45-degree field of view: 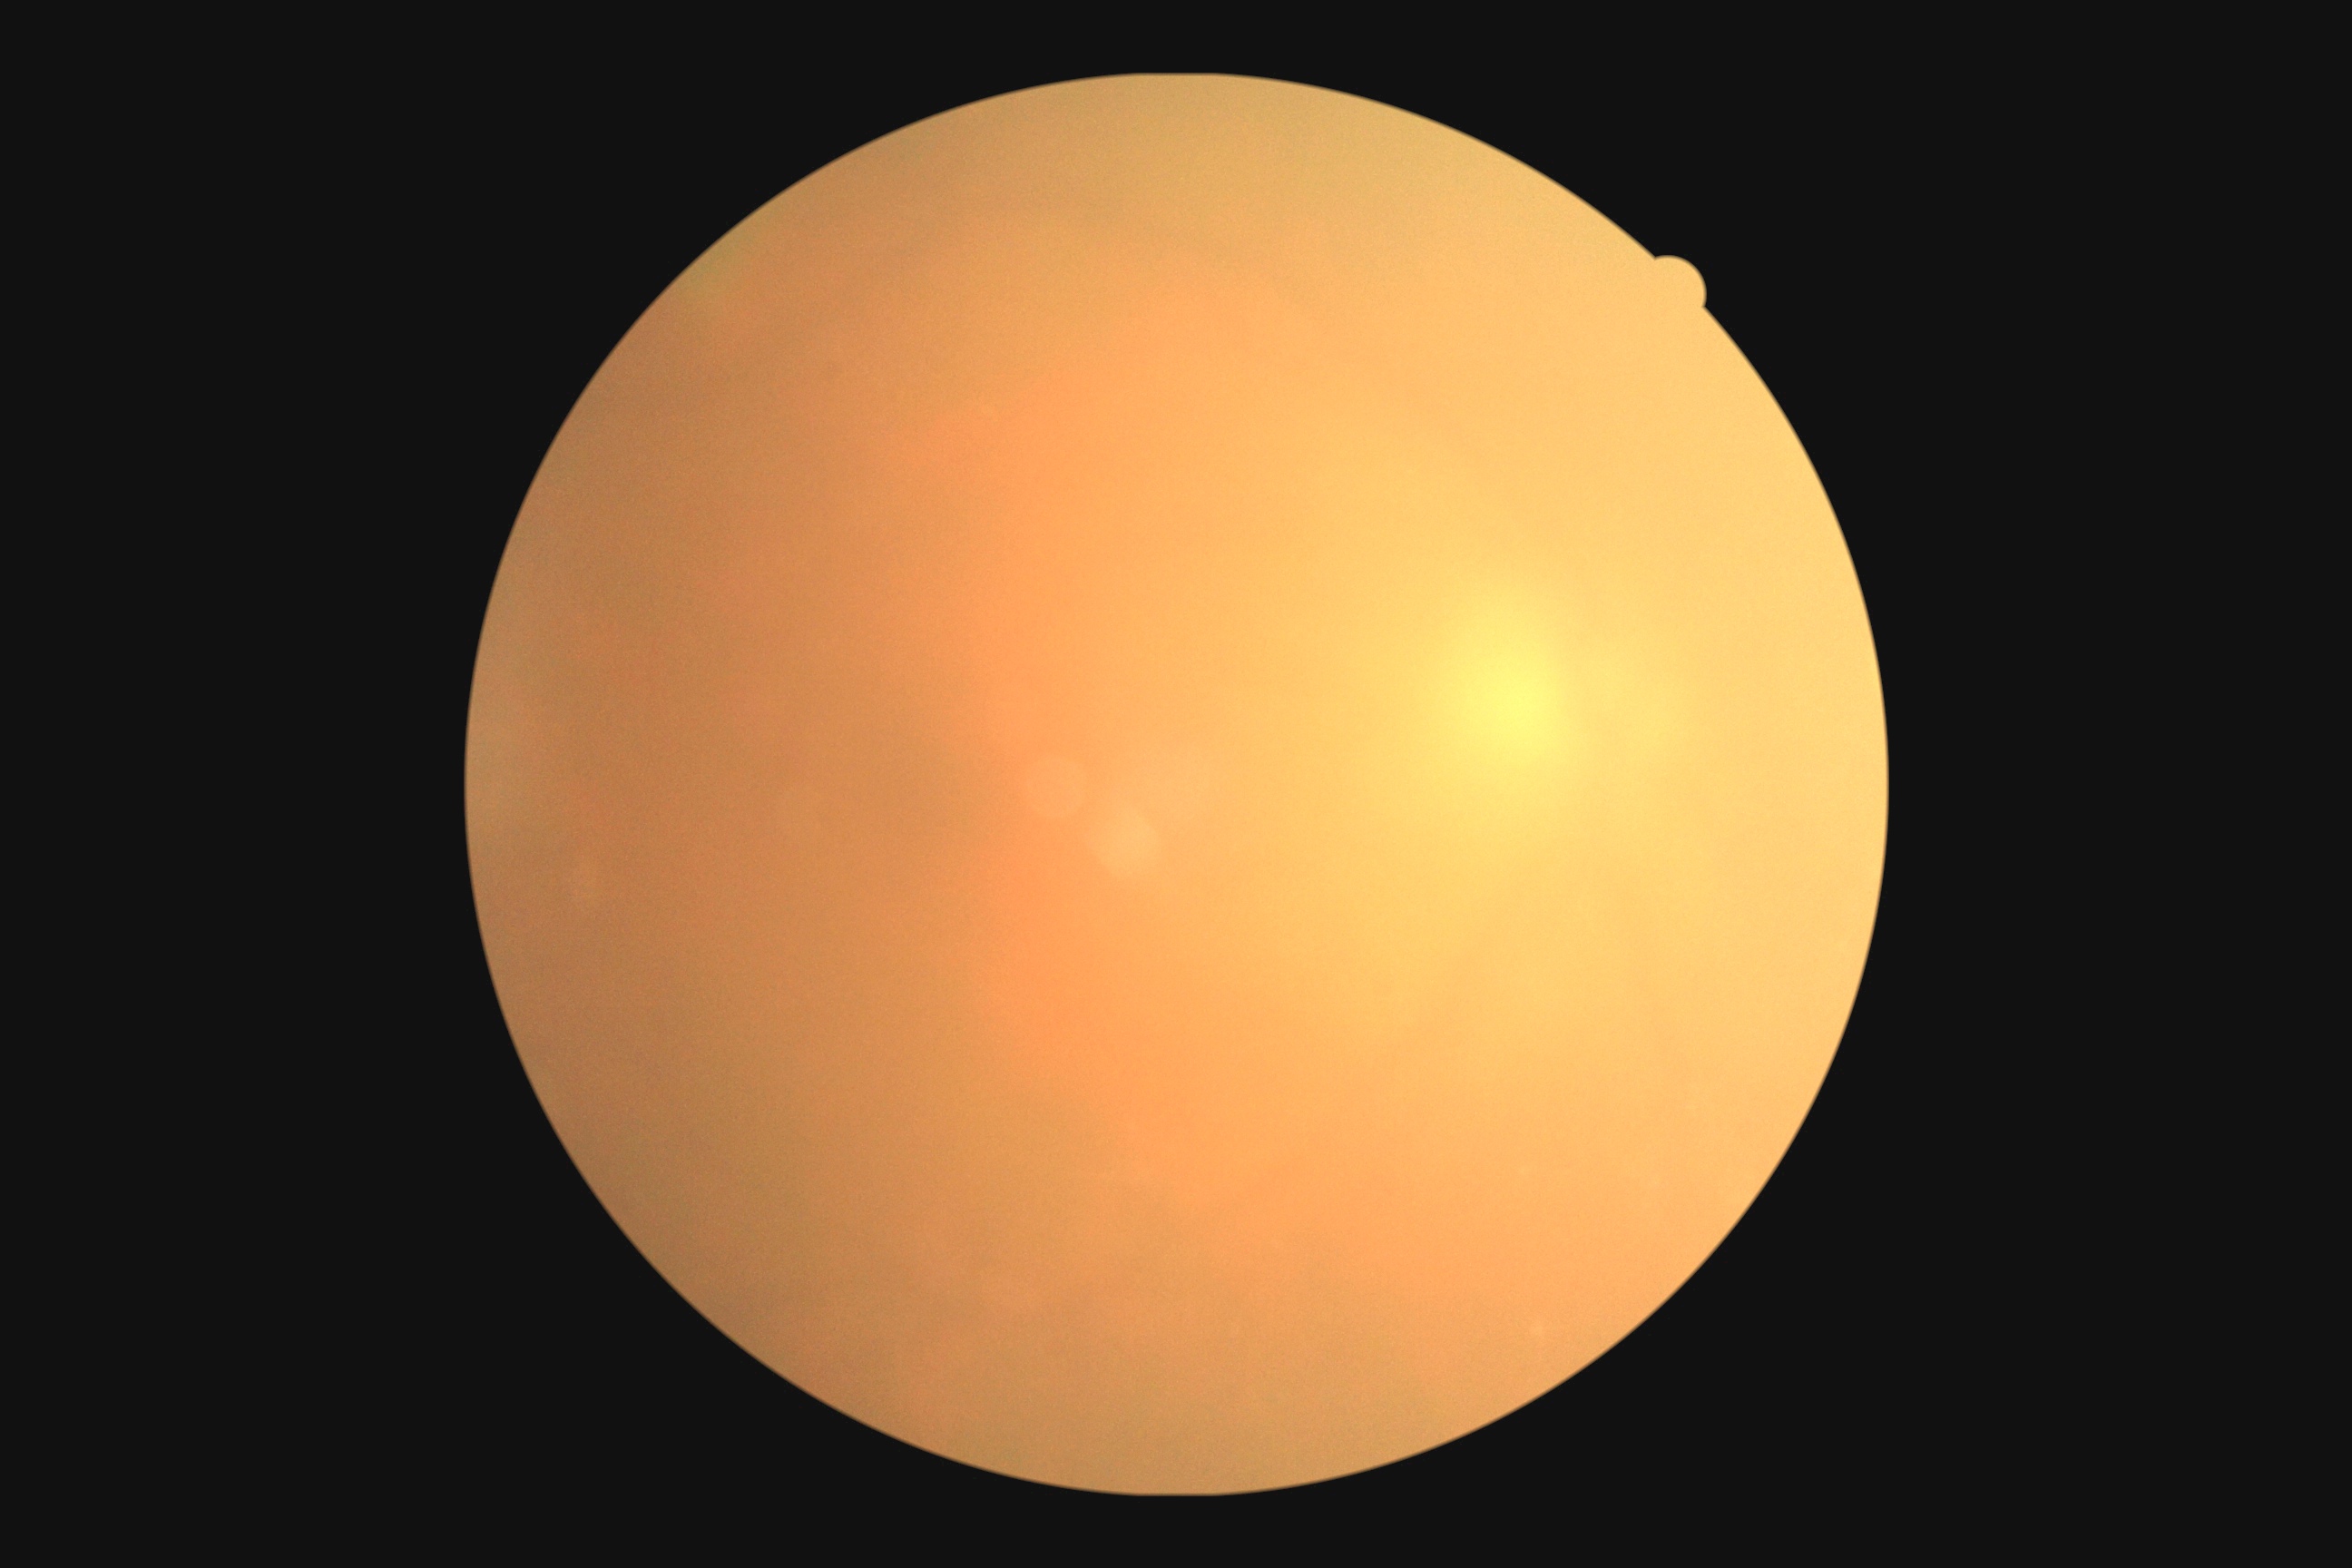 {"quality": "insufficient", "dr_grade": "ungradable due to poor image quality"}